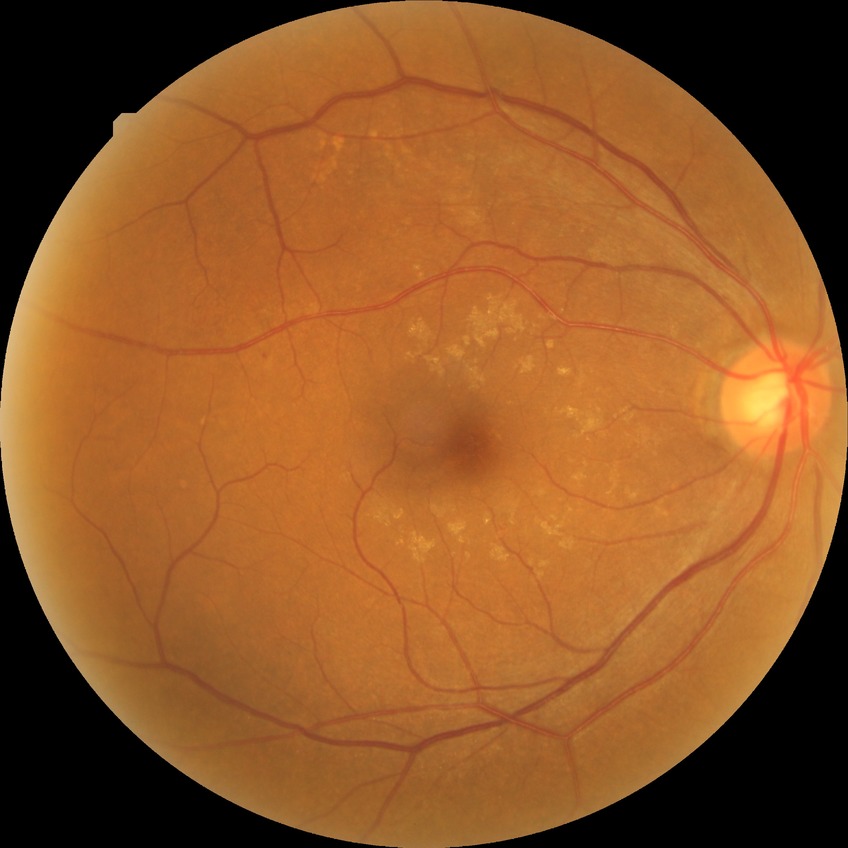 diabetic retinopathy (DR) = NDR (no diabetic retinopathy).